CFP. 45° FOV:
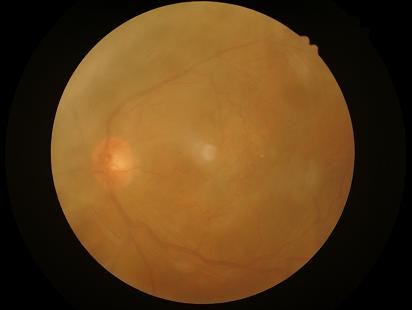 Overall quality is poor; the image is difficult to grade. Illumination is even. Noticeable blur in the optic disc, vessels, or background. Narrow intensity range; structures are hard to distinguish.